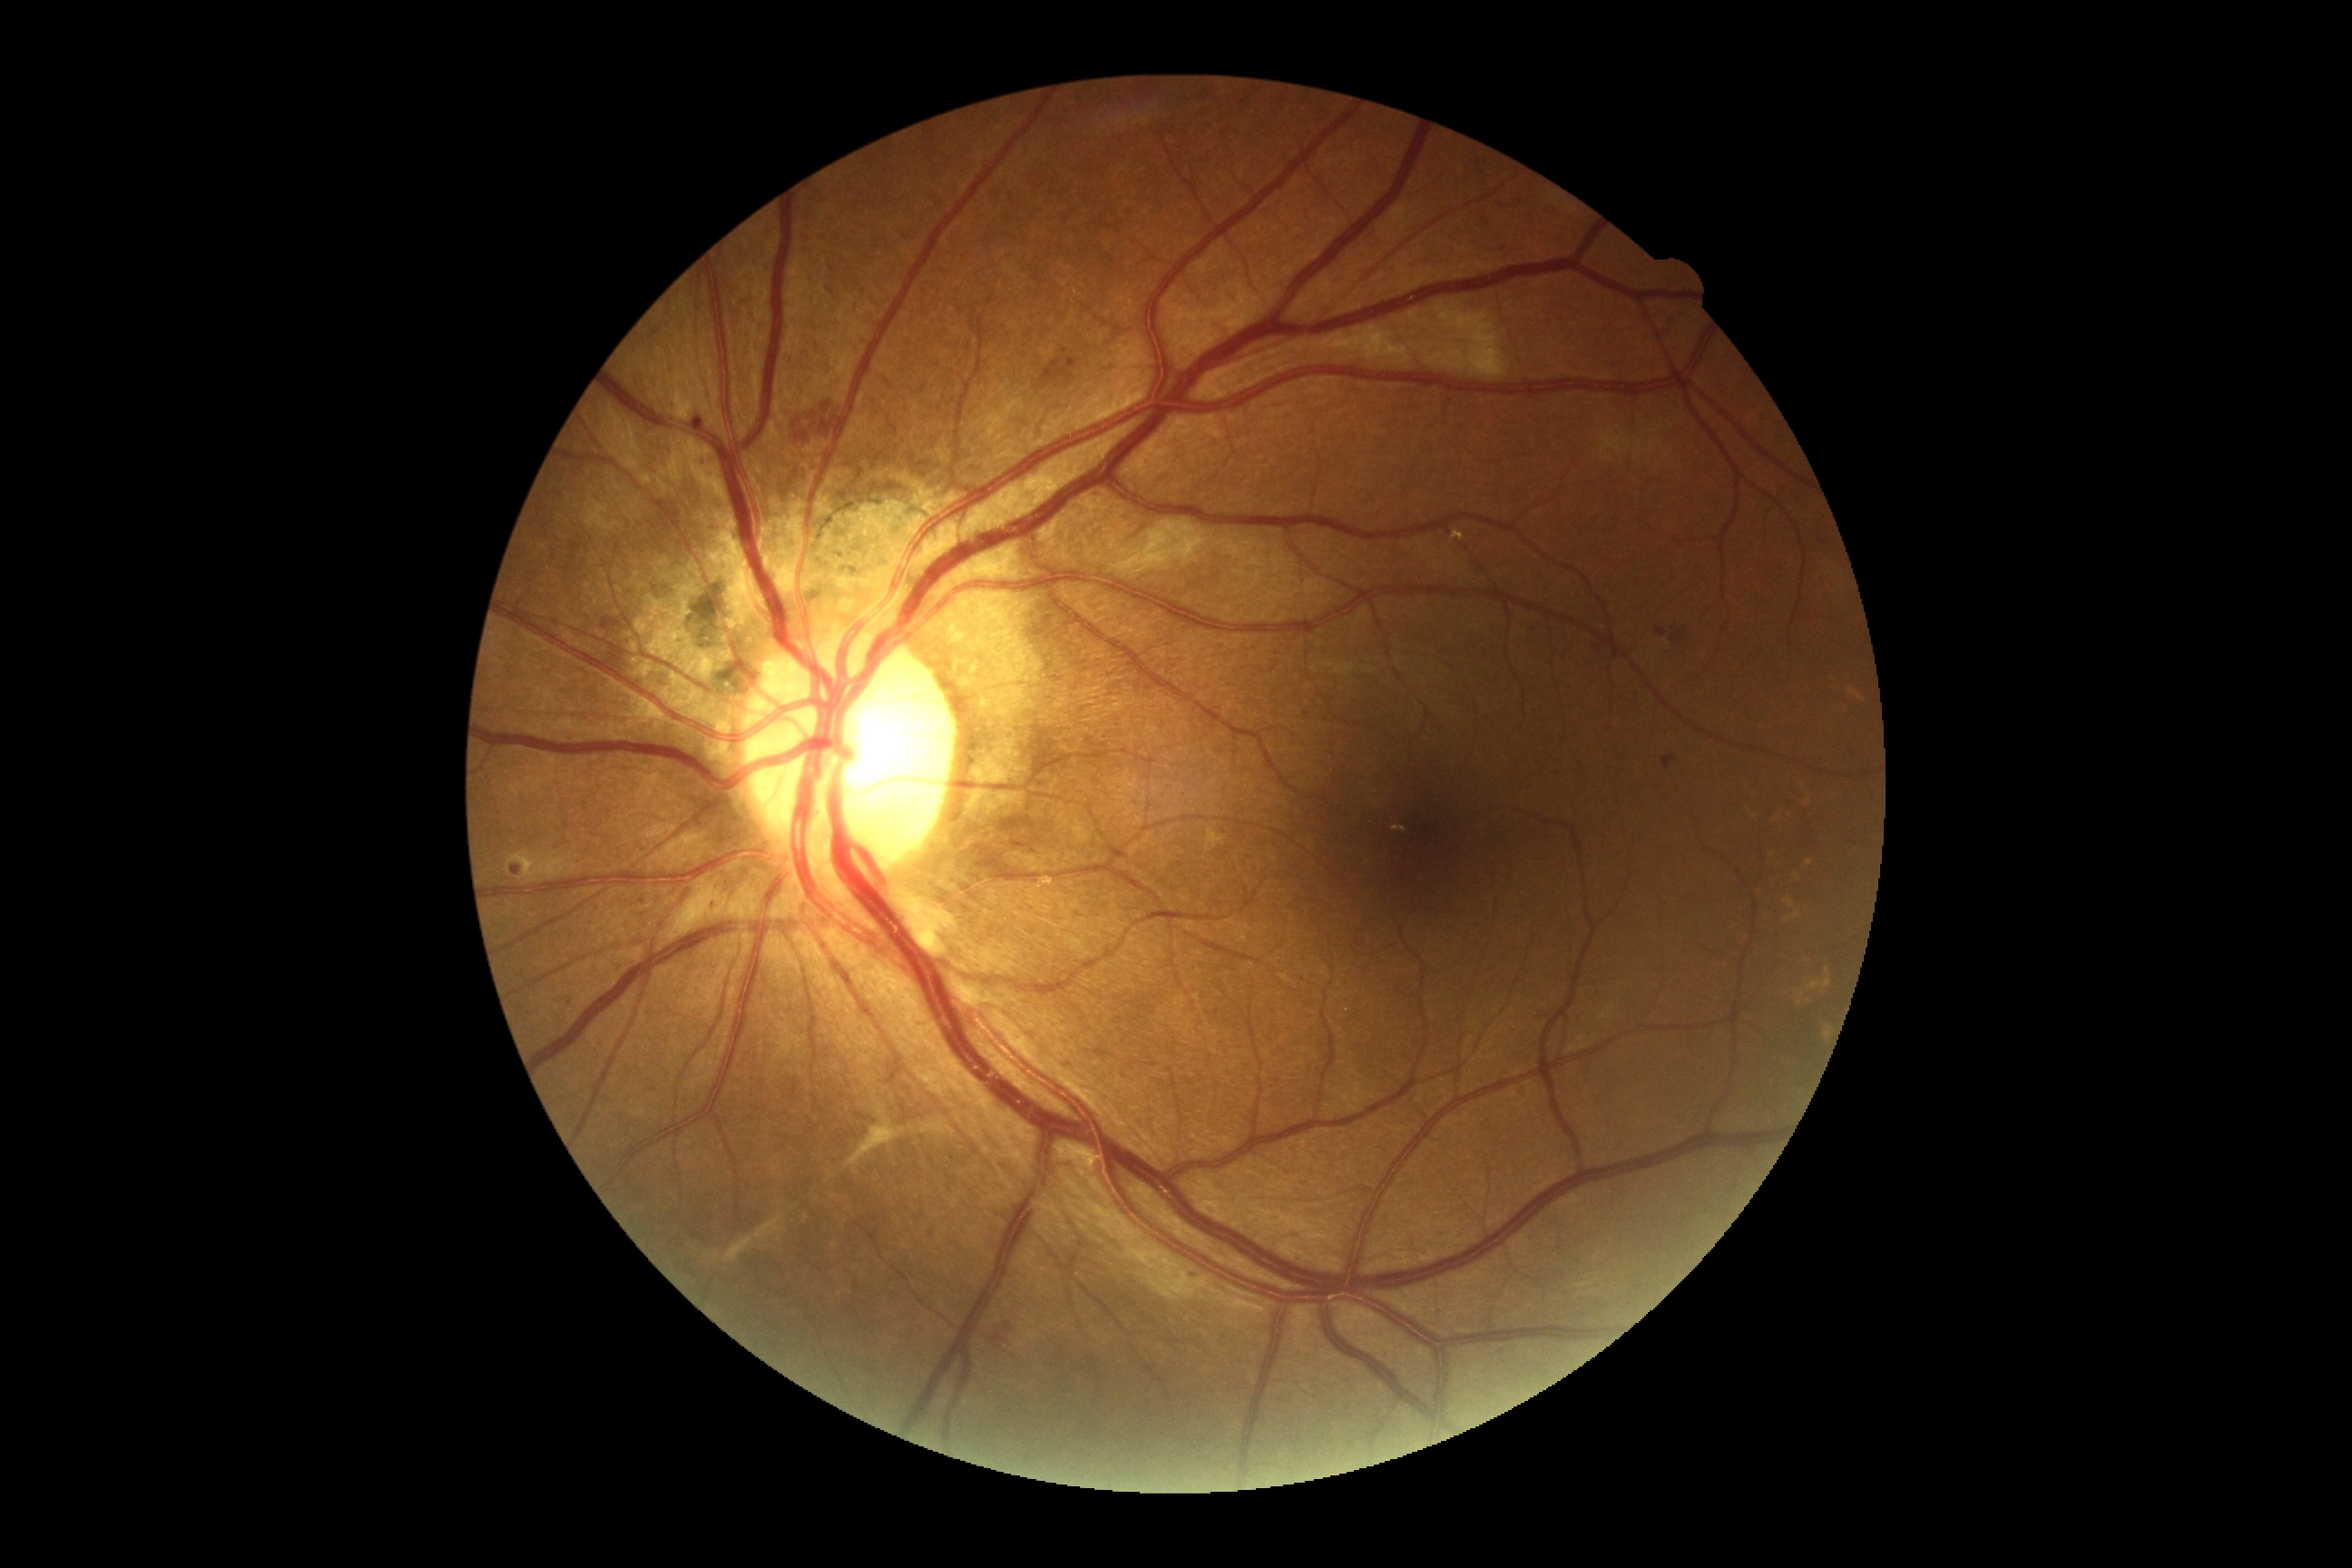

DR grade is 2 — more than just microaneurysms but less than severe NPDR.